CFP, 45° FOV
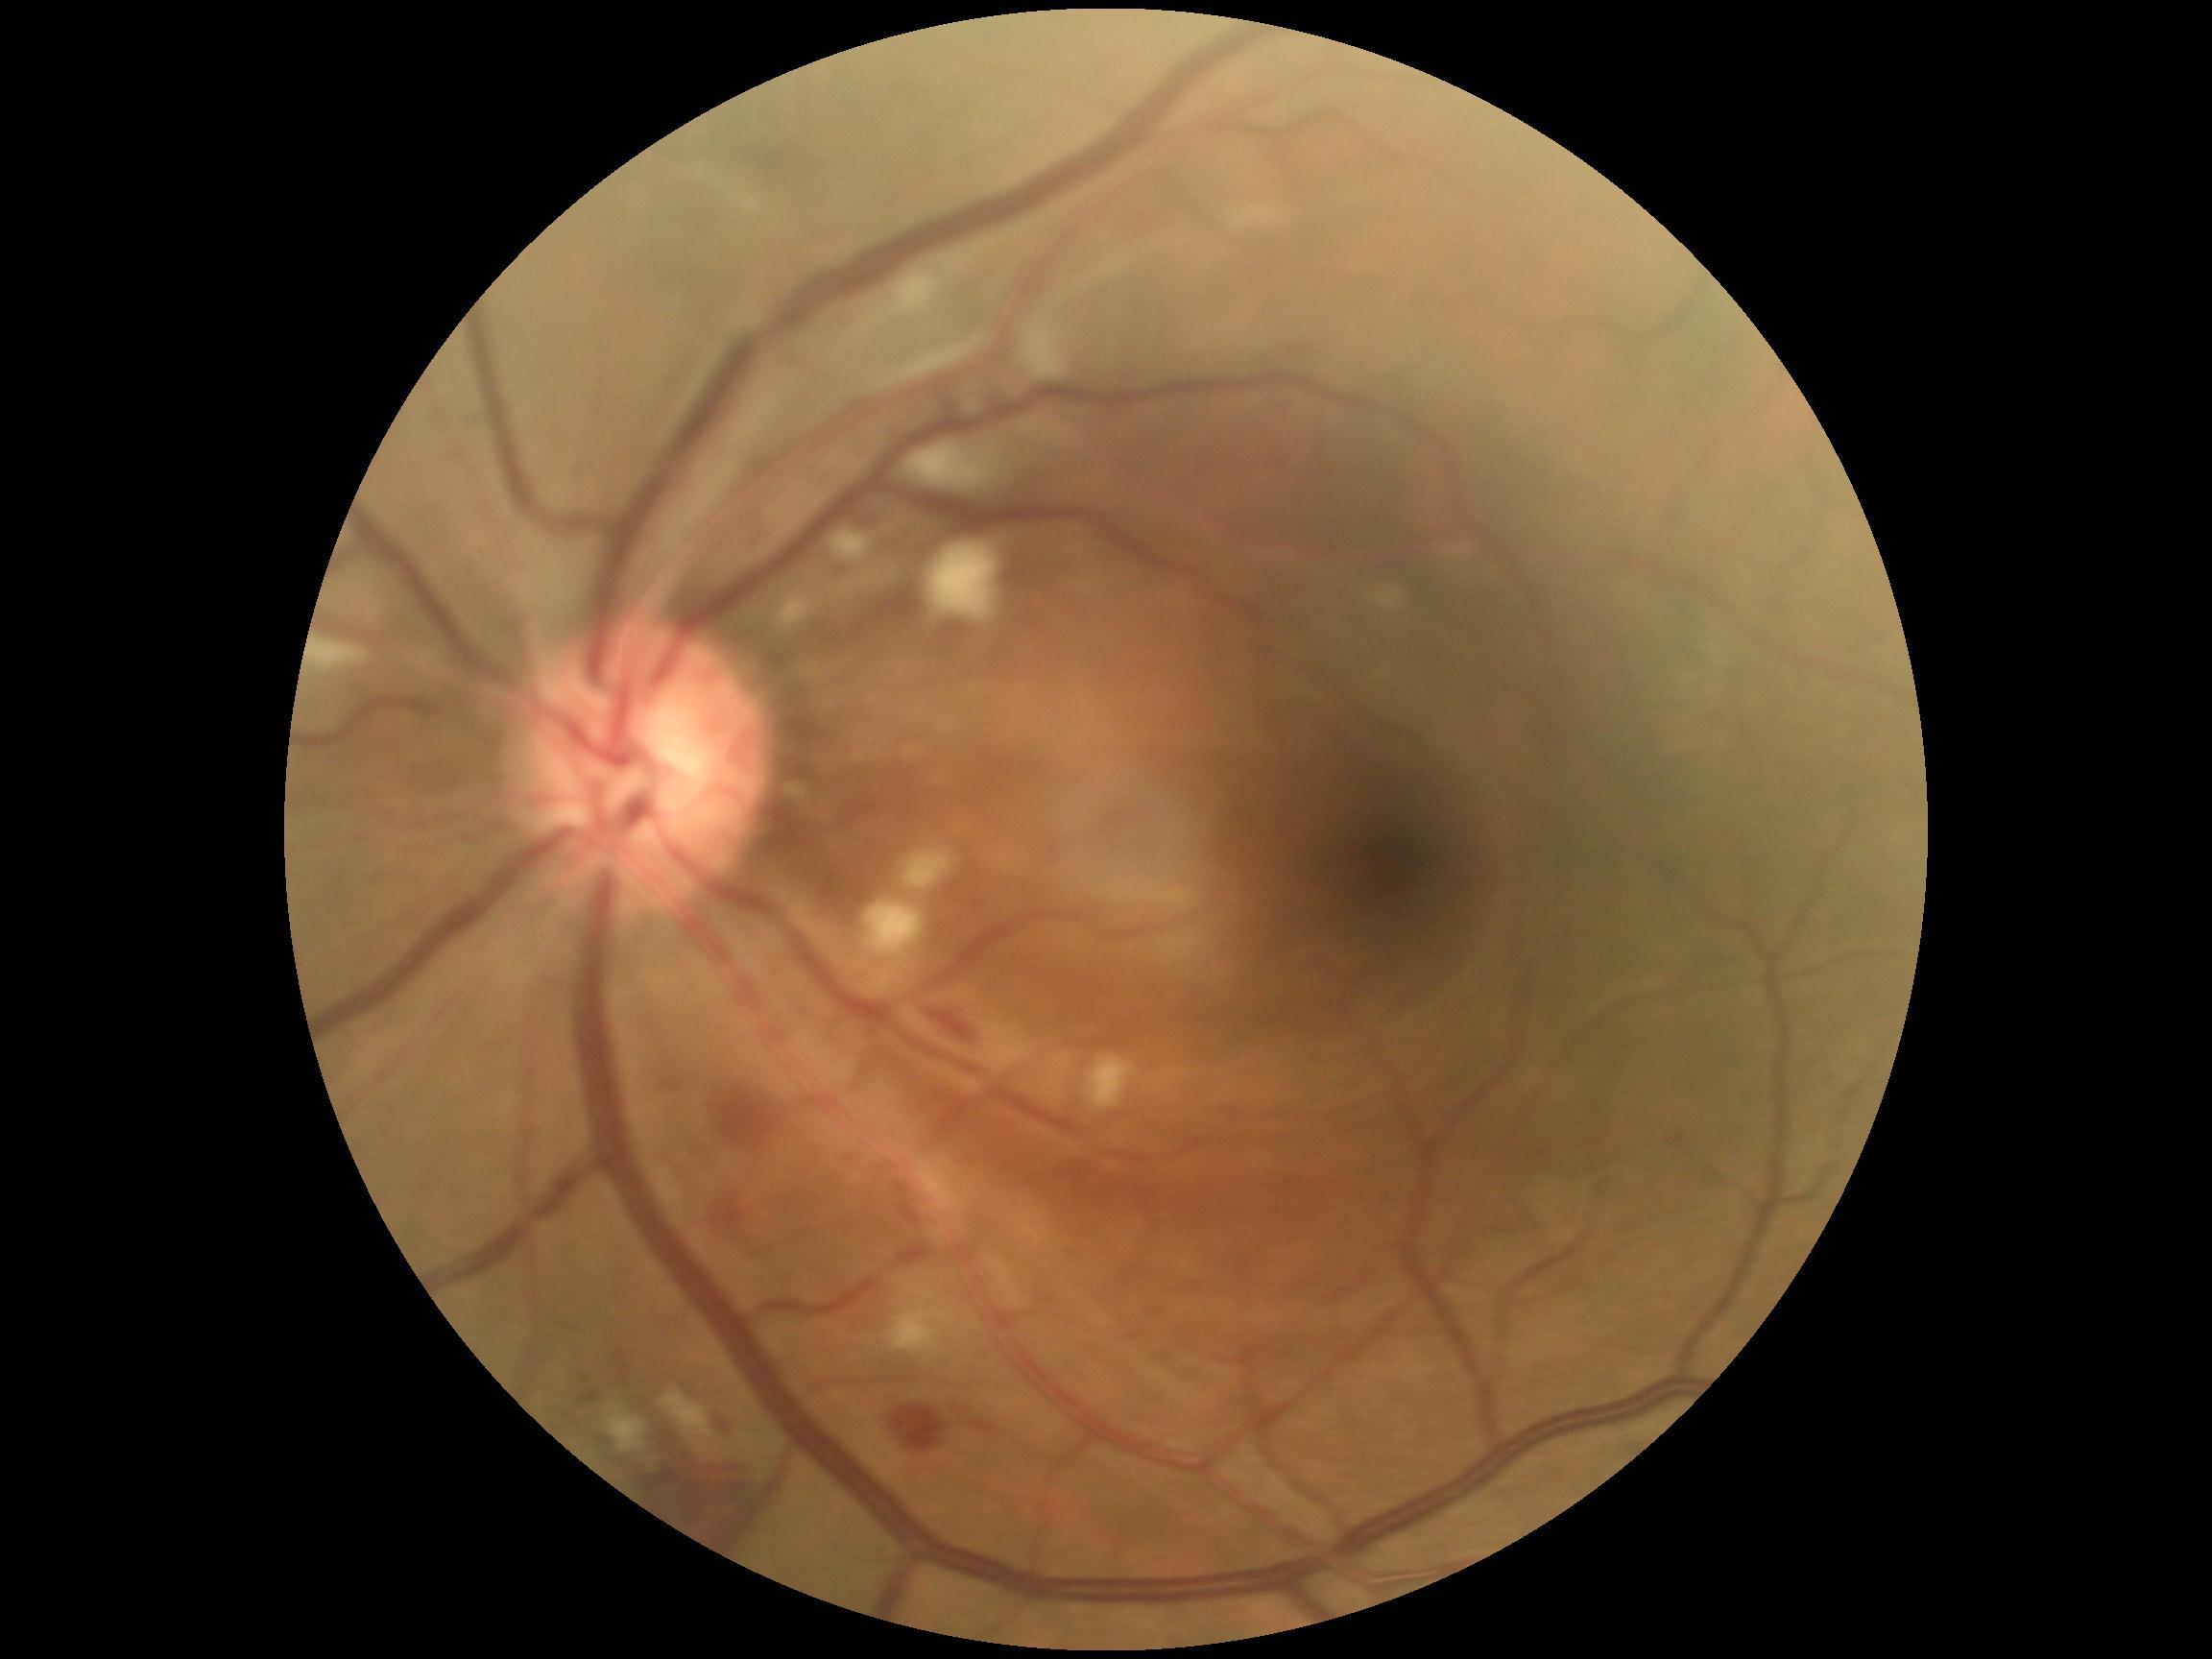
Diabetic retinopathy severity: 2.